45° FOV; 848 x 848 pixels; no pharmacologic dilation
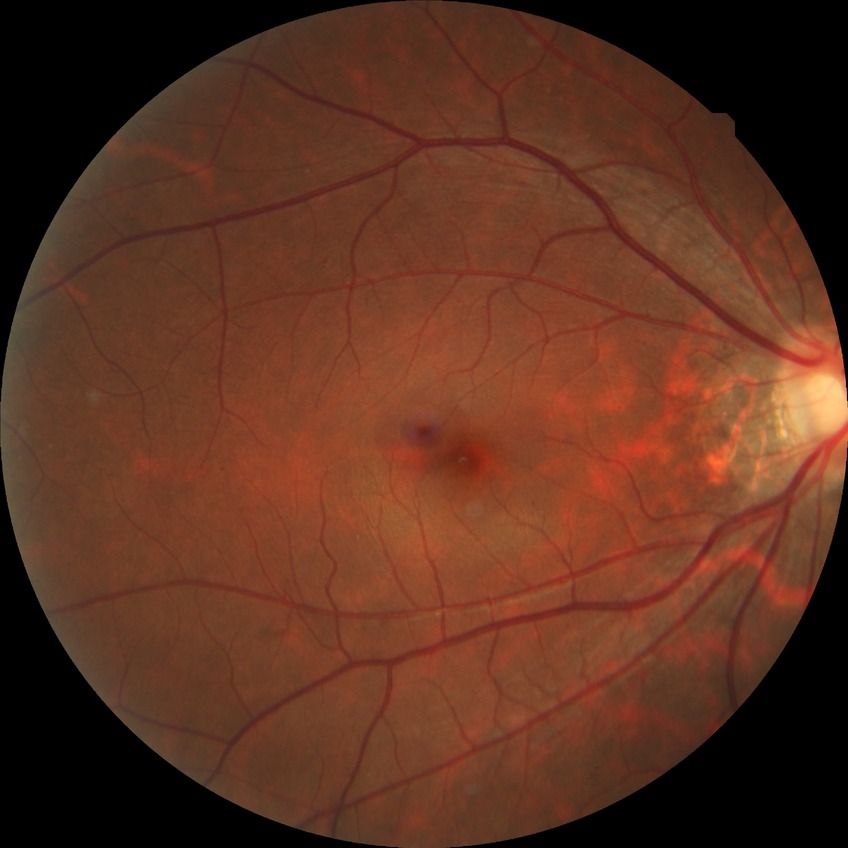 diabetic retinopathy (DR): simple diabetic retinopathy (SDR).